CFP. 1971 by 1876 pixels
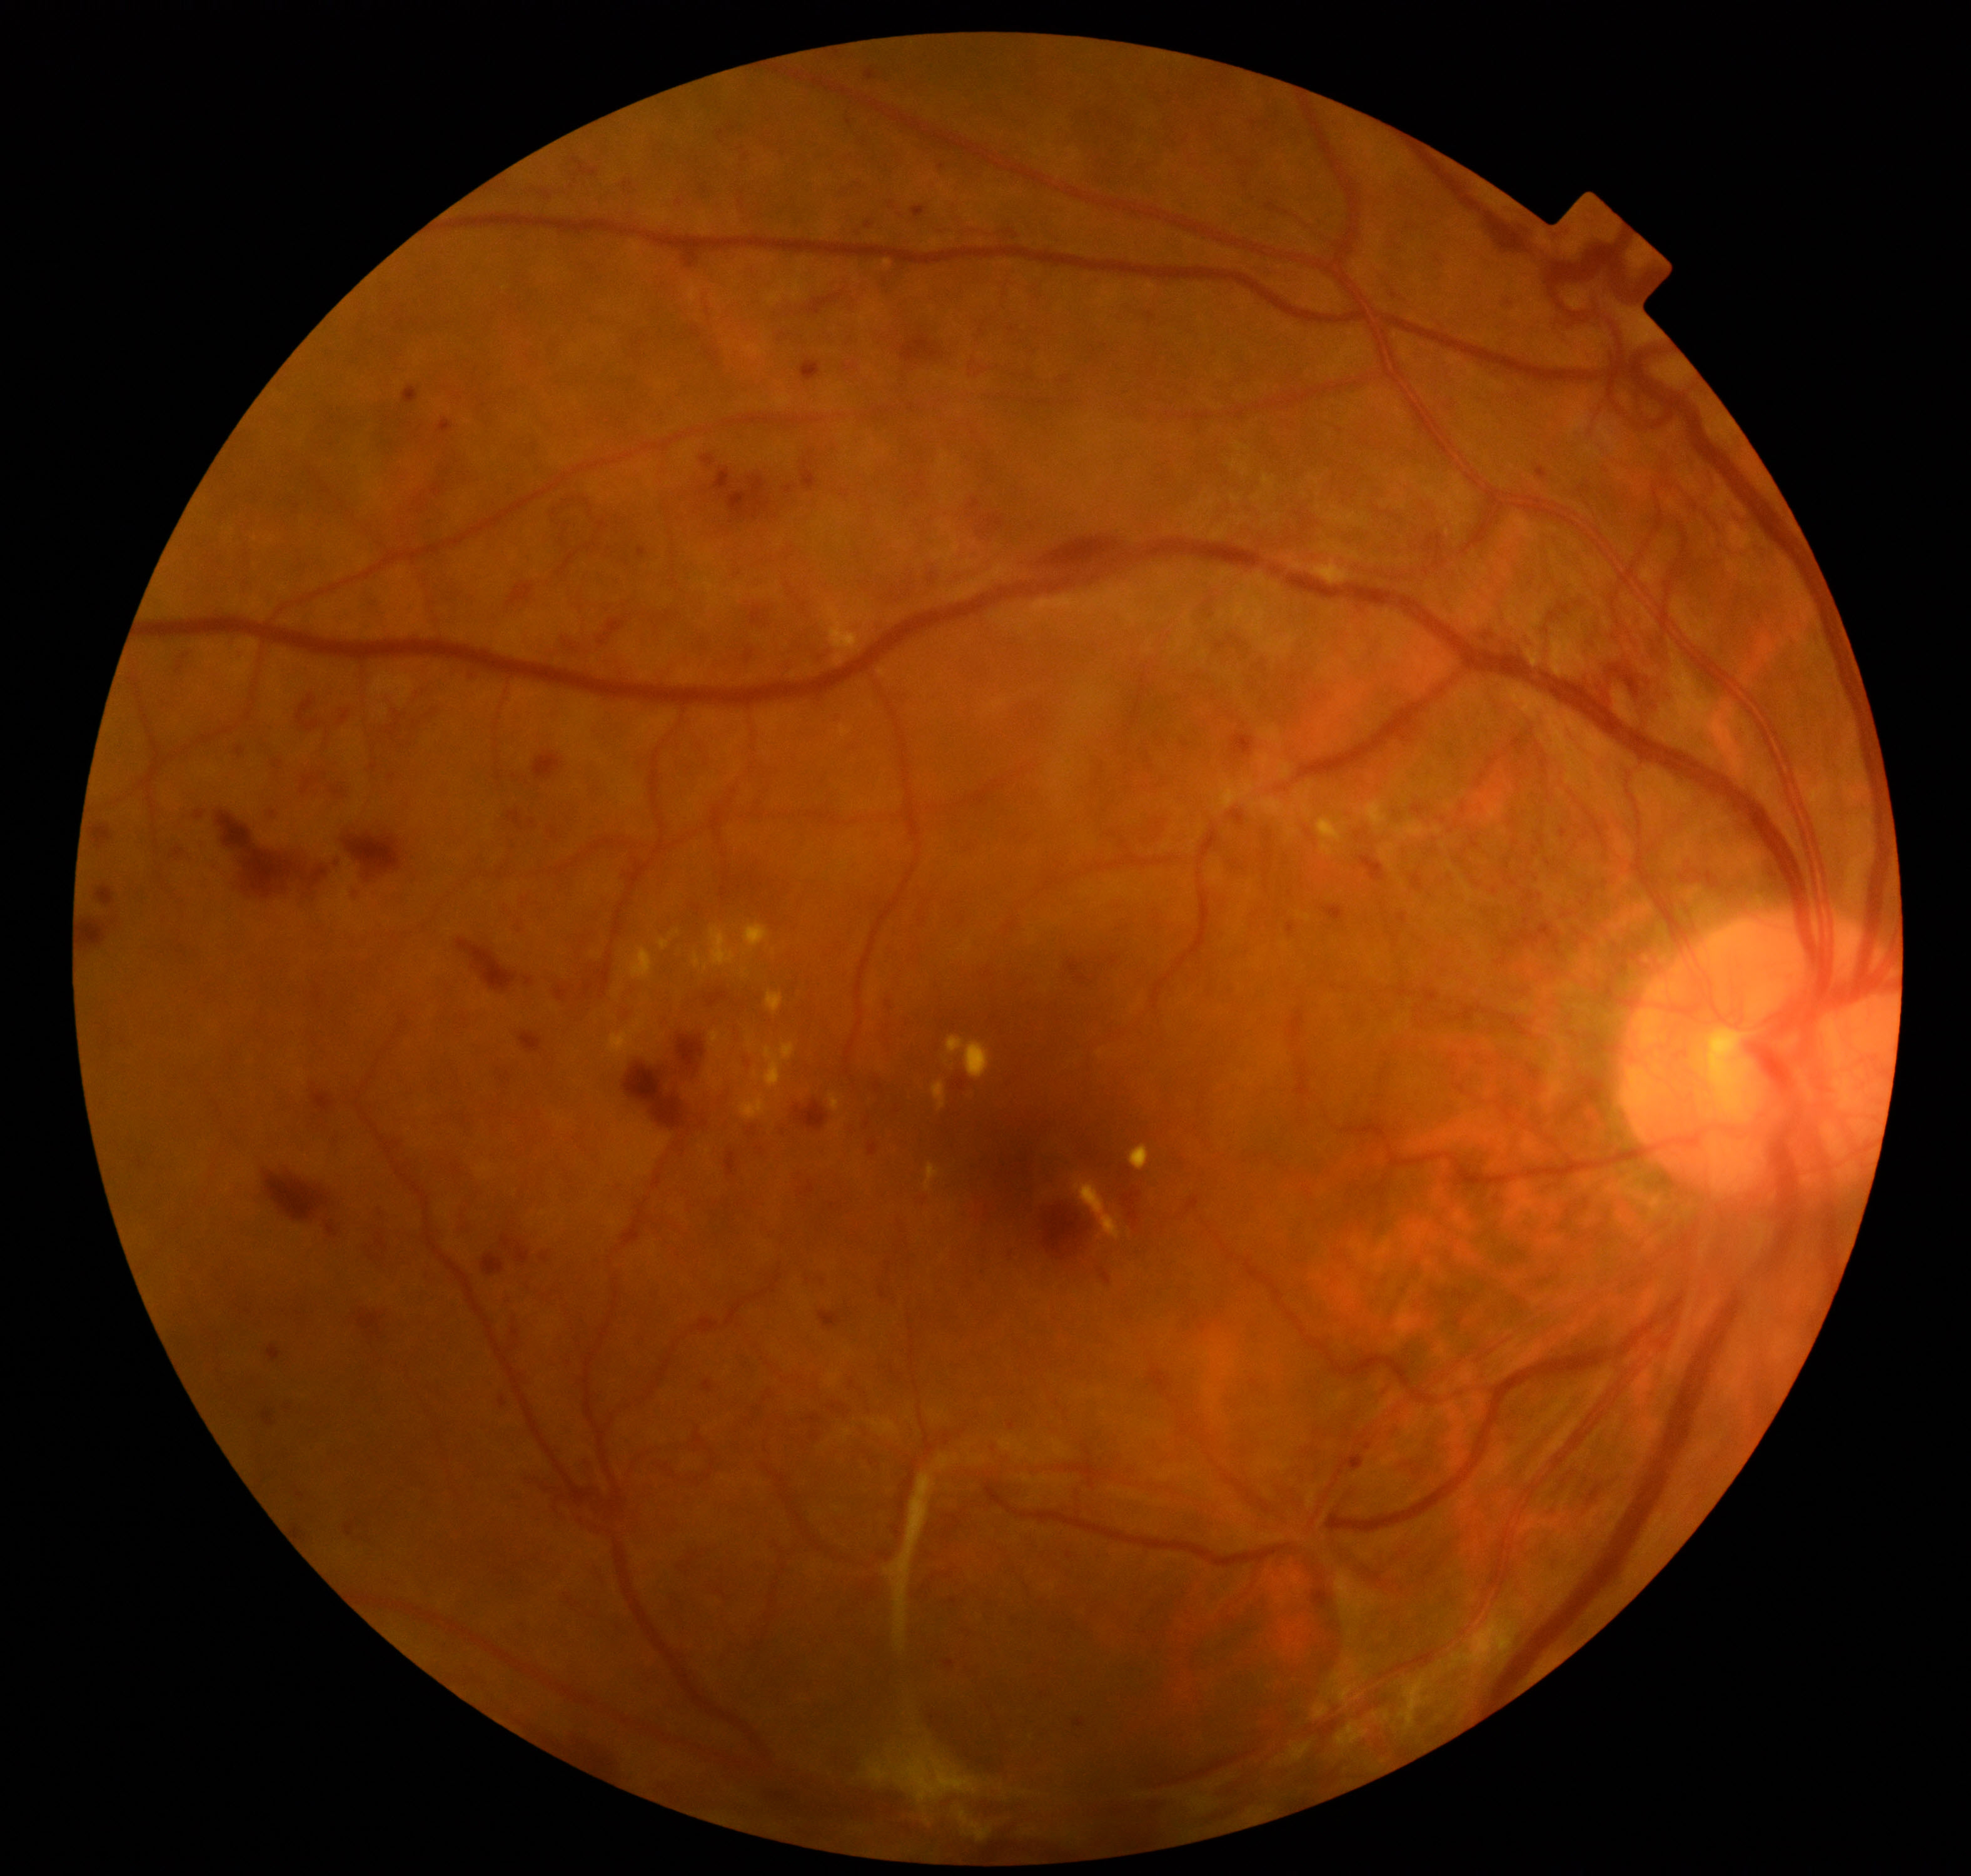
Findings: severe non-proliferative or proliferative diabetic retinopathy.